45° field of view; fundus photo; 2352x1568px: 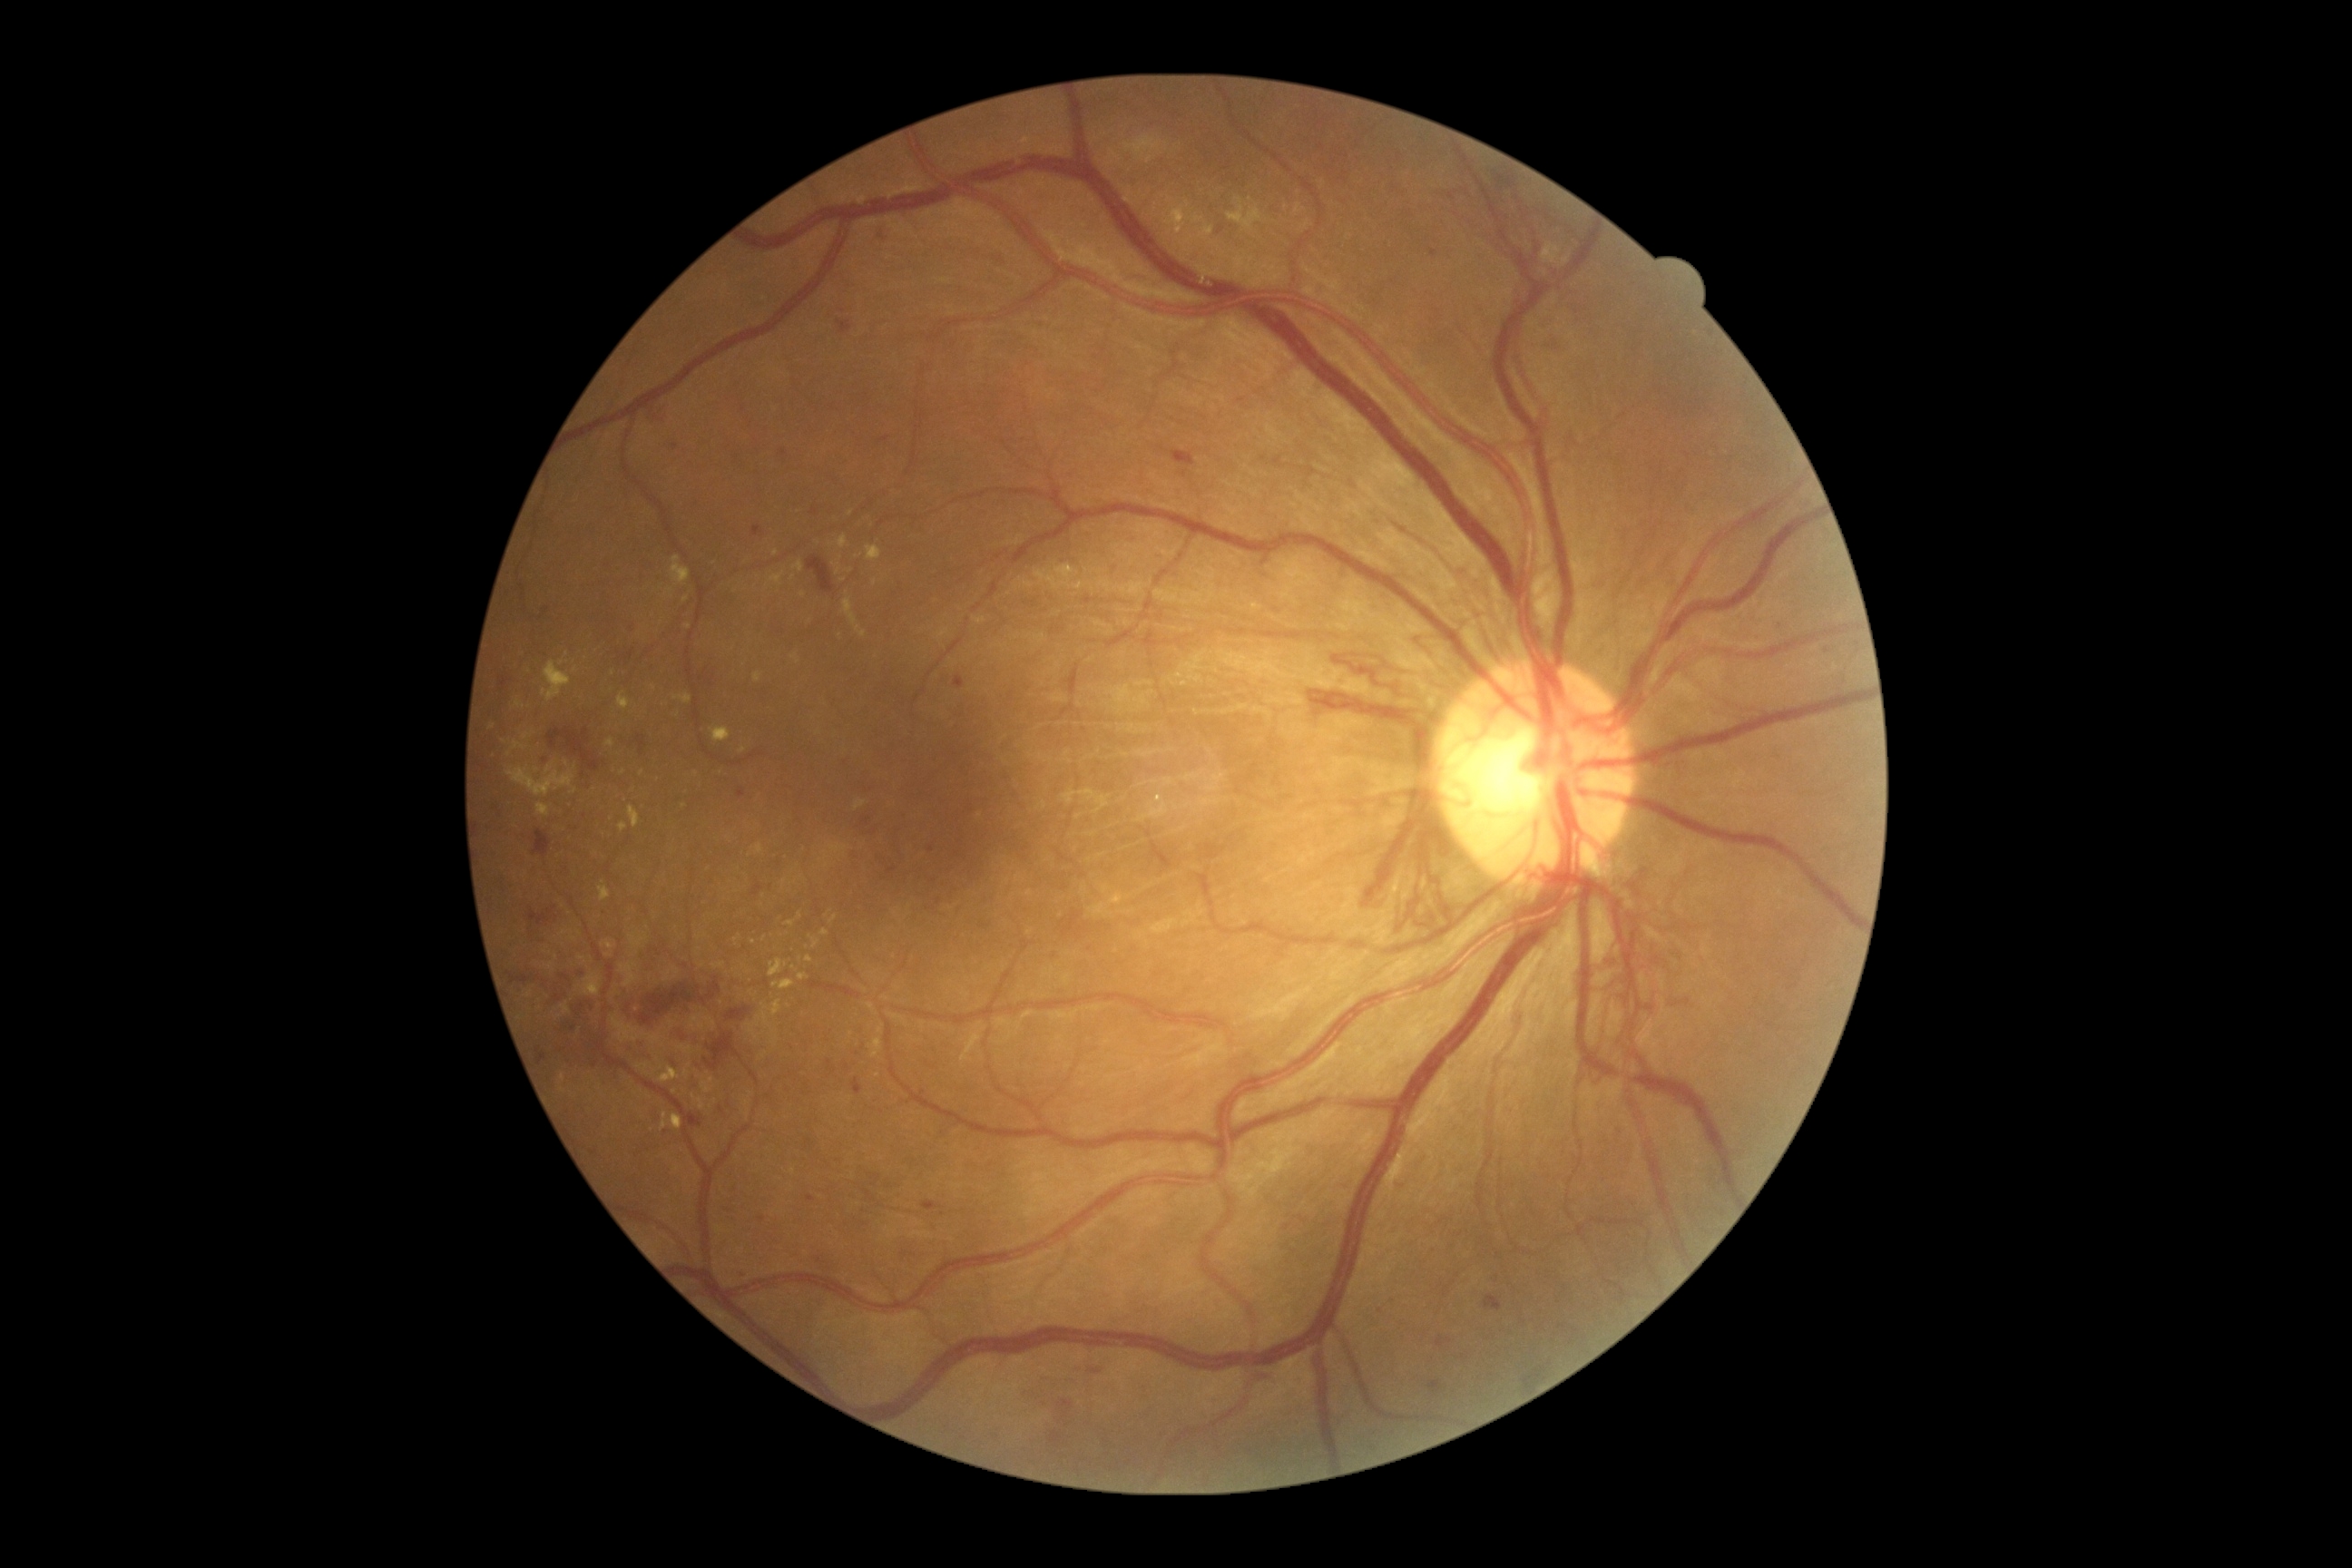

  dr_grade: PDR (grade 4)